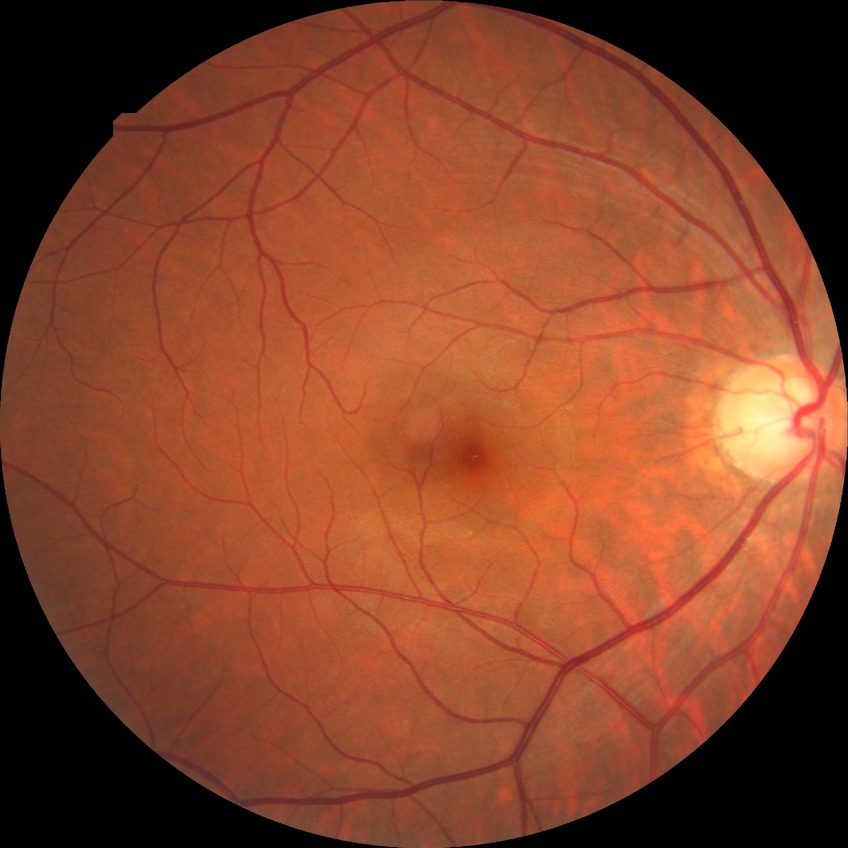

– diabetic retinopathy (DR) — no diabetic retinopathy (NDR)